45° field of view. 848x848px:
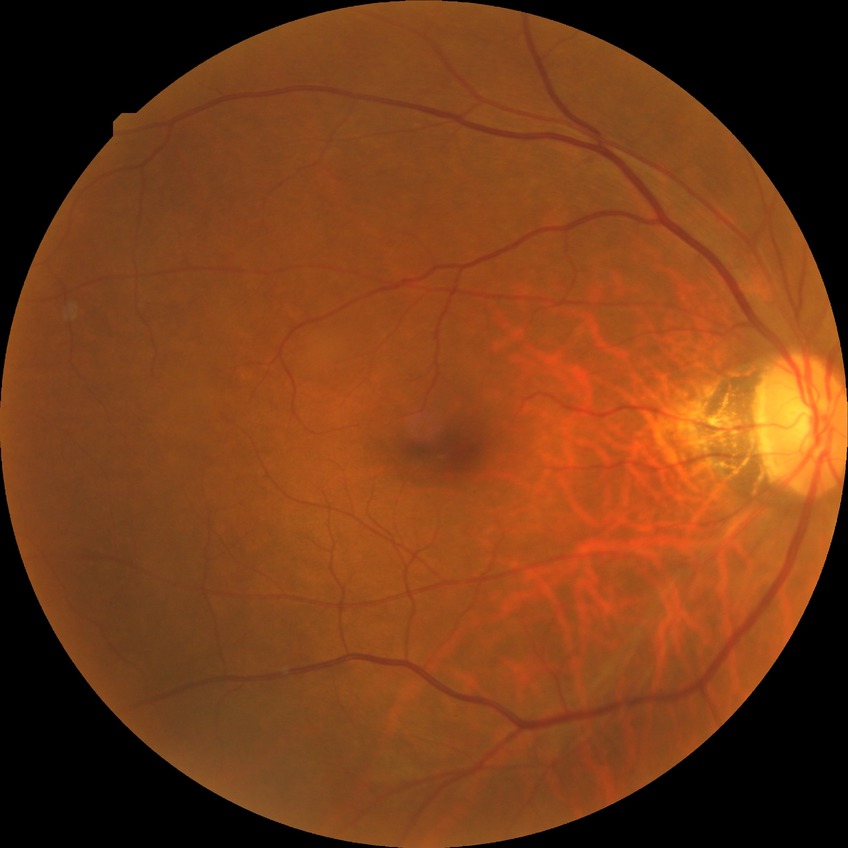

Diabetic retinopathy (DR) is NDR (no diabetic retinopathy).